45° FOV, NIDEK AFC-230, image size 848x848, Davis DR grading — 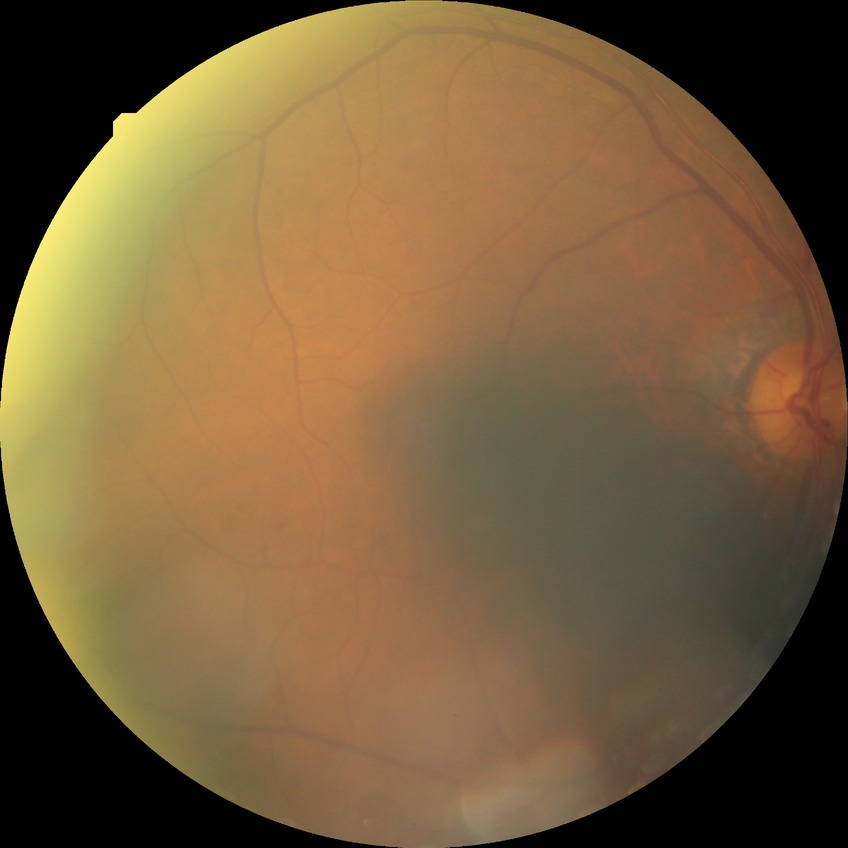
Diabetic retinopathy (DR) is simple diabetic retinopathy (SDR).
DR class: non-proliferative diabetic retinopathy.